Acquired on the Clarity RetCam 3. RetCam wide-field infant fundus image.
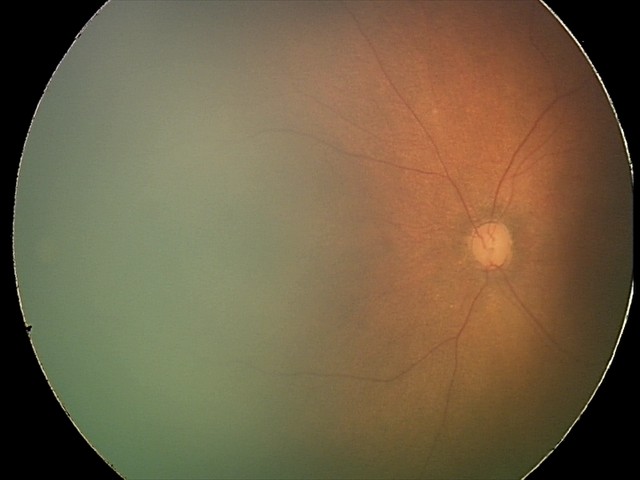

No retinal pathology identified on screening.